NIDEK AFC-230 fundus camera.
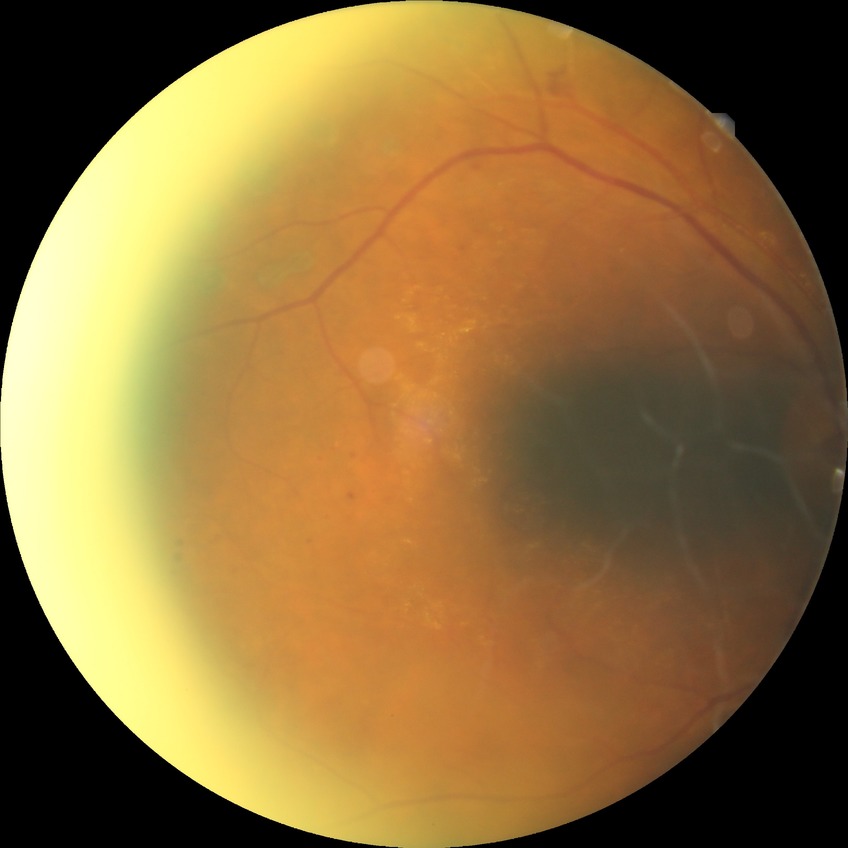 DR is PDR.